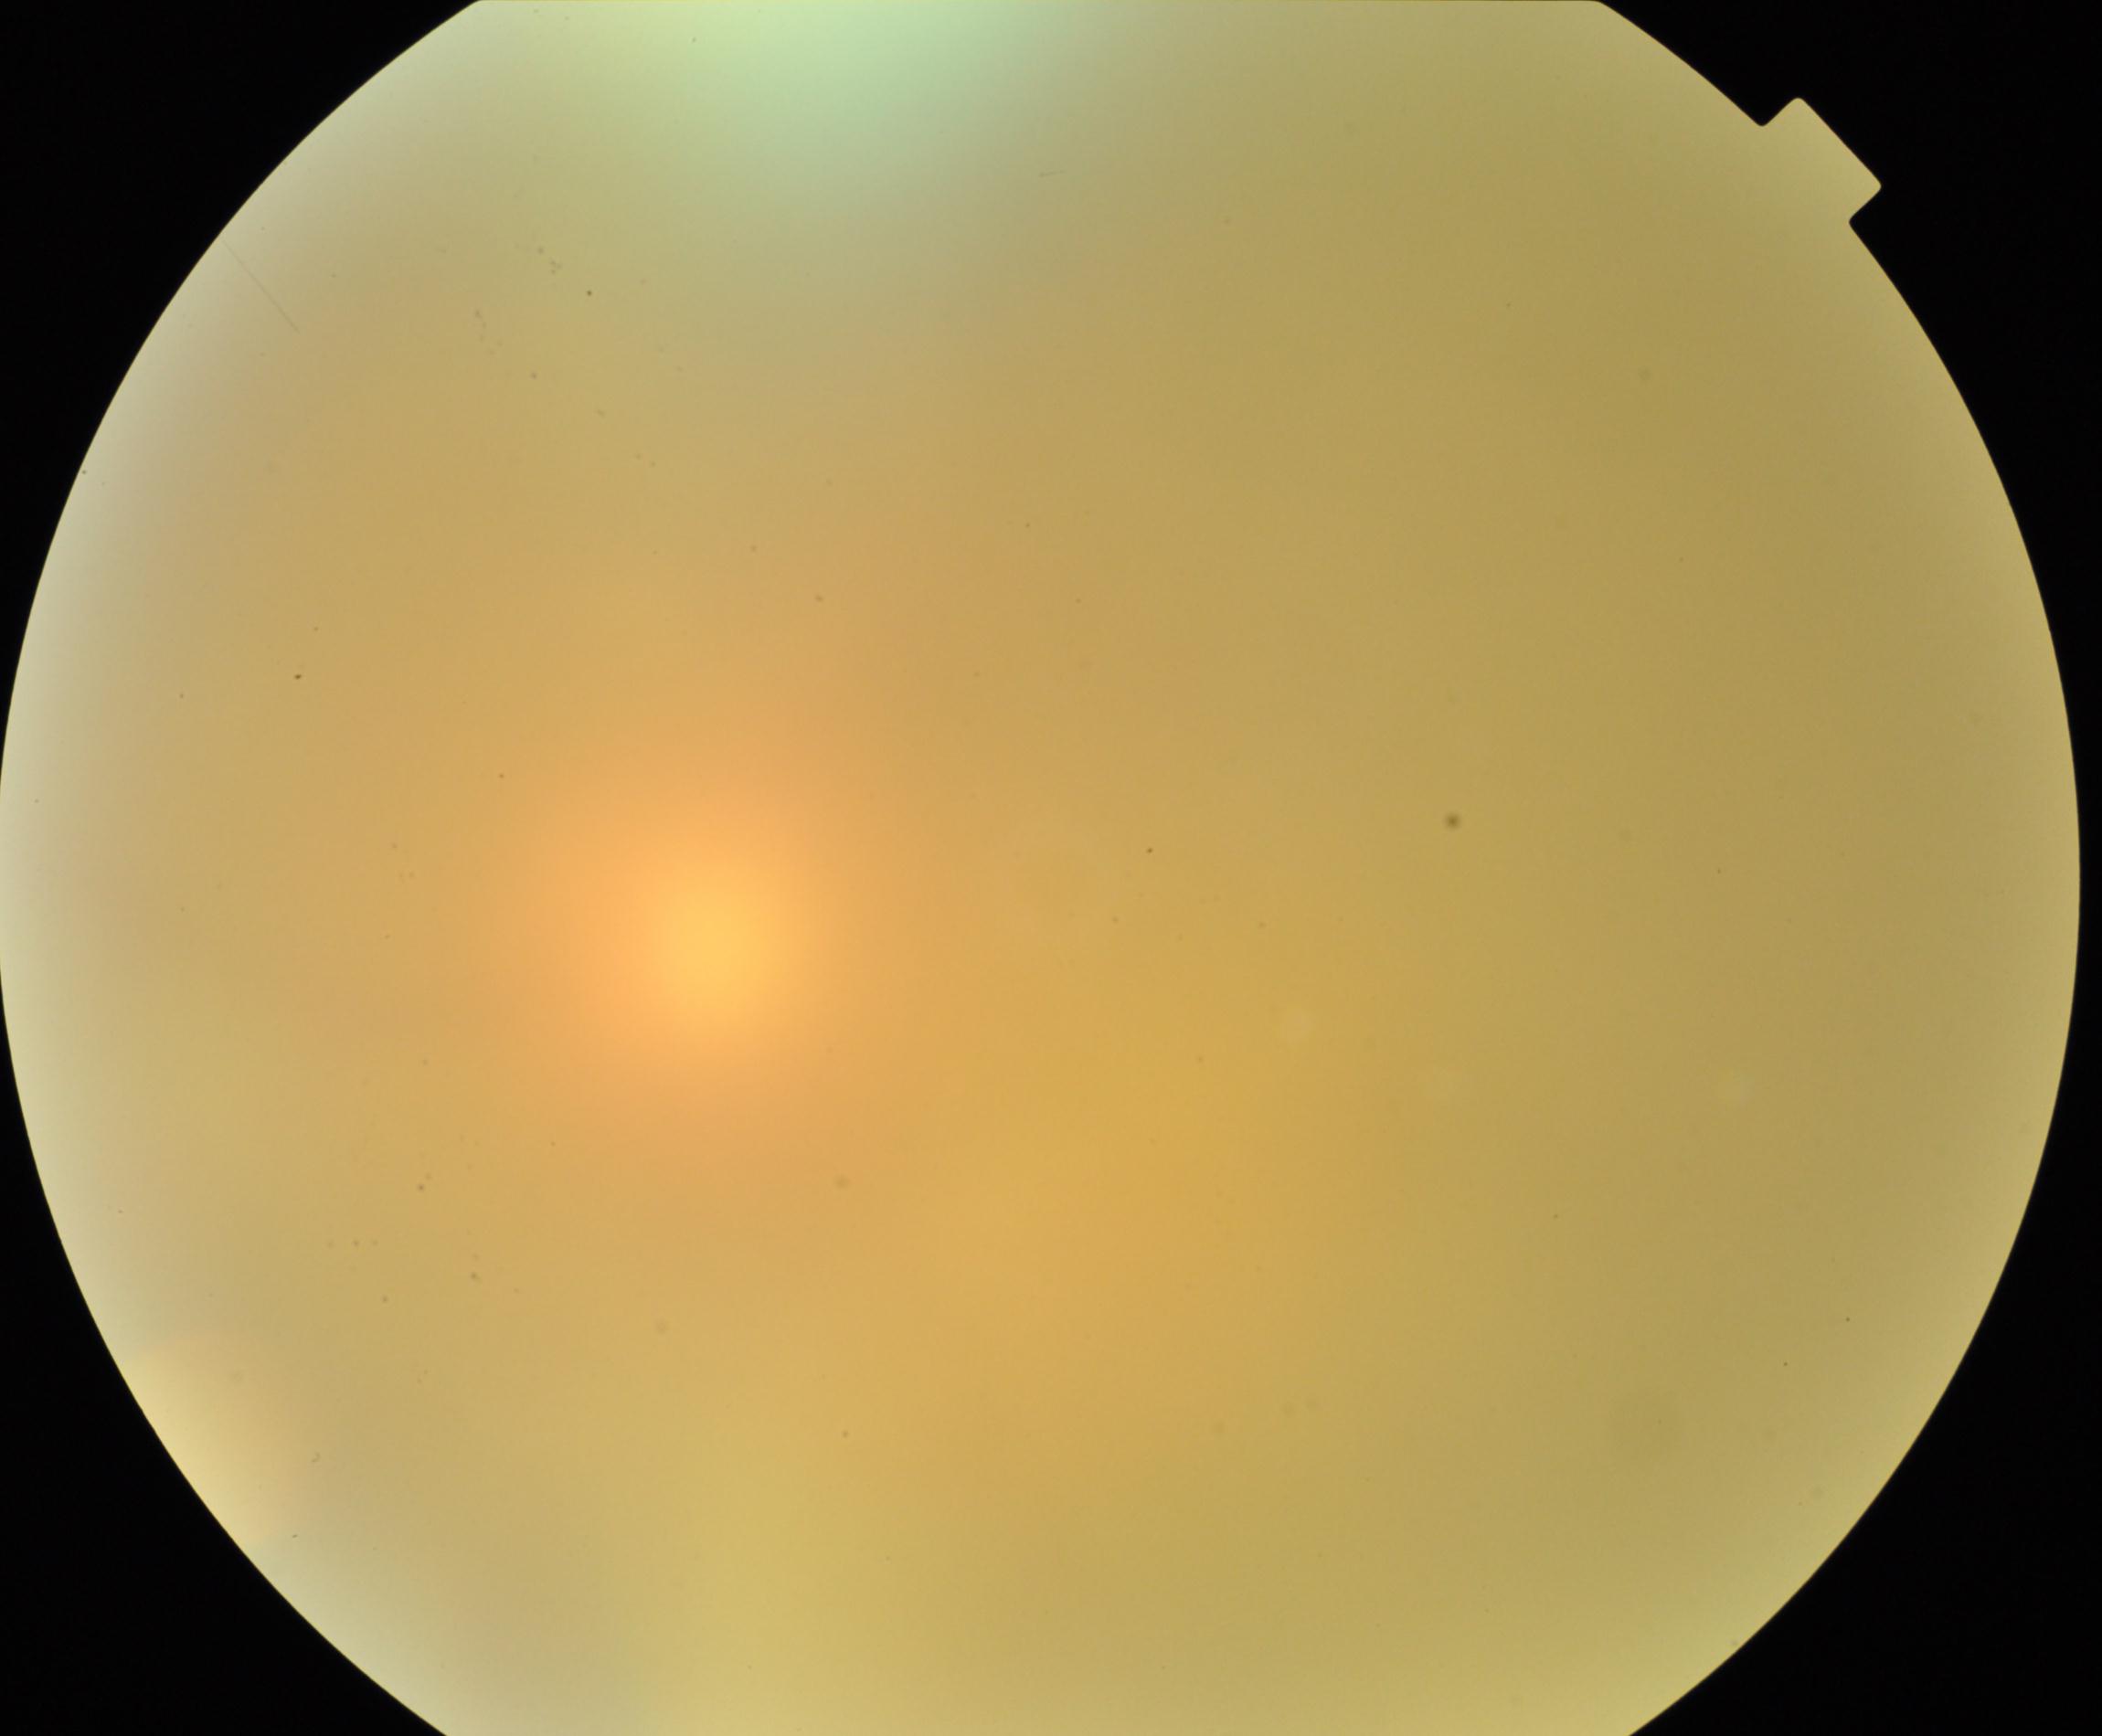
Blurred fundus image with substantial obscuration of retinal landmarks. No evidence of proliferative diabetic retinopathy.